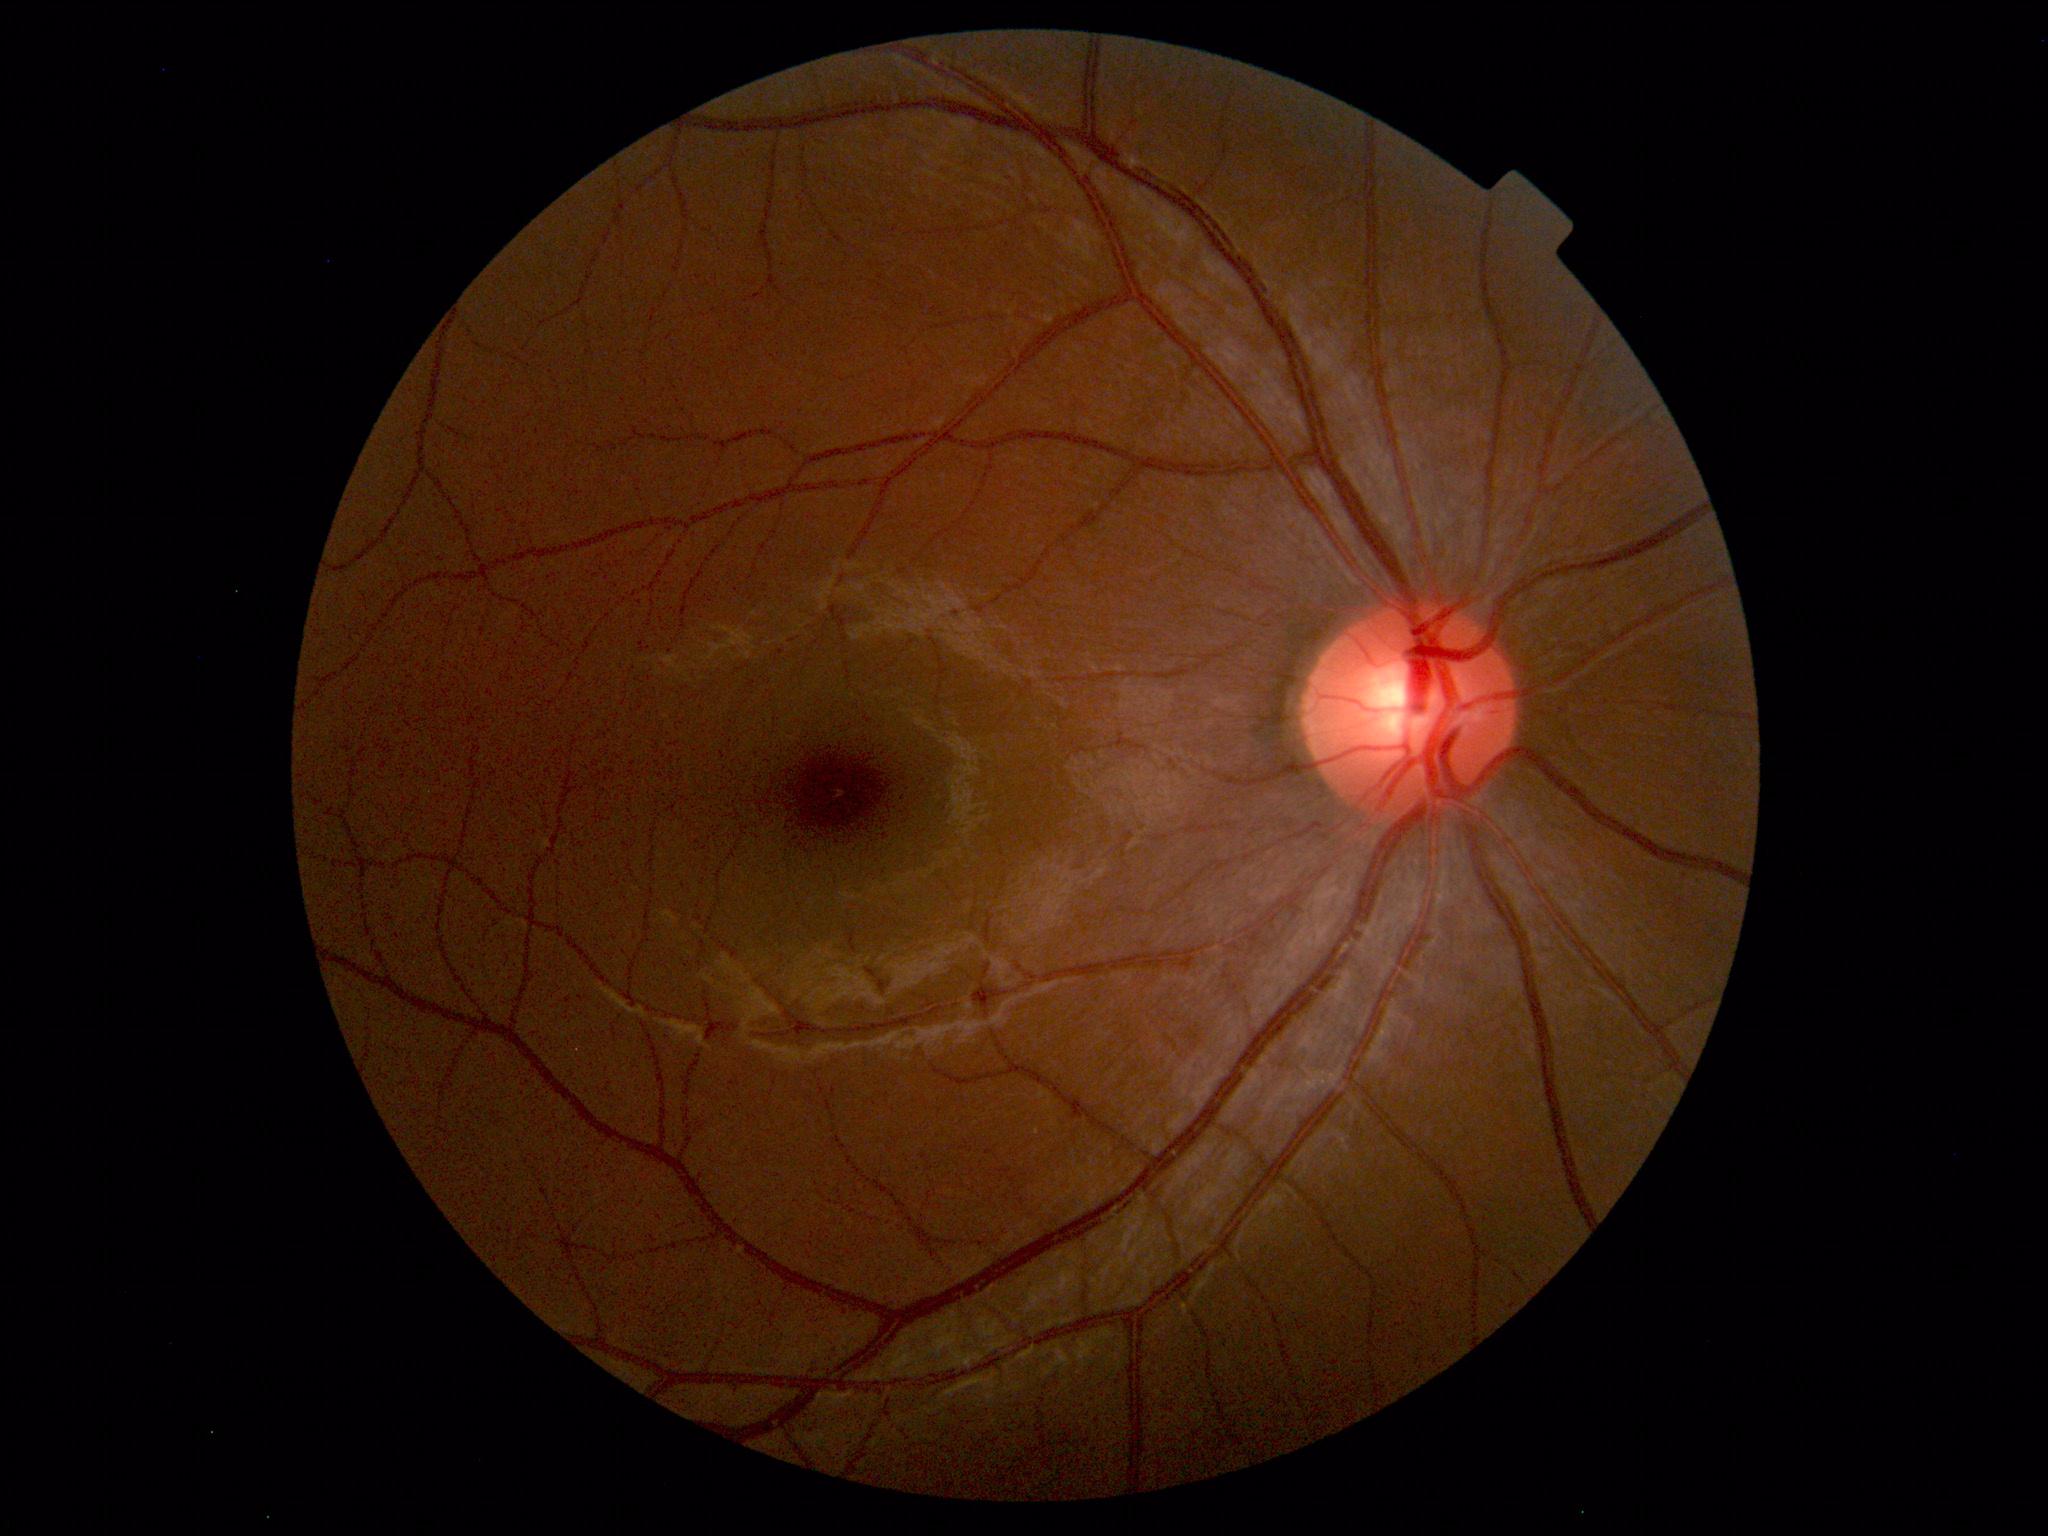
Unremarkable color fundus photograph.